2352 by 1568 pixels — 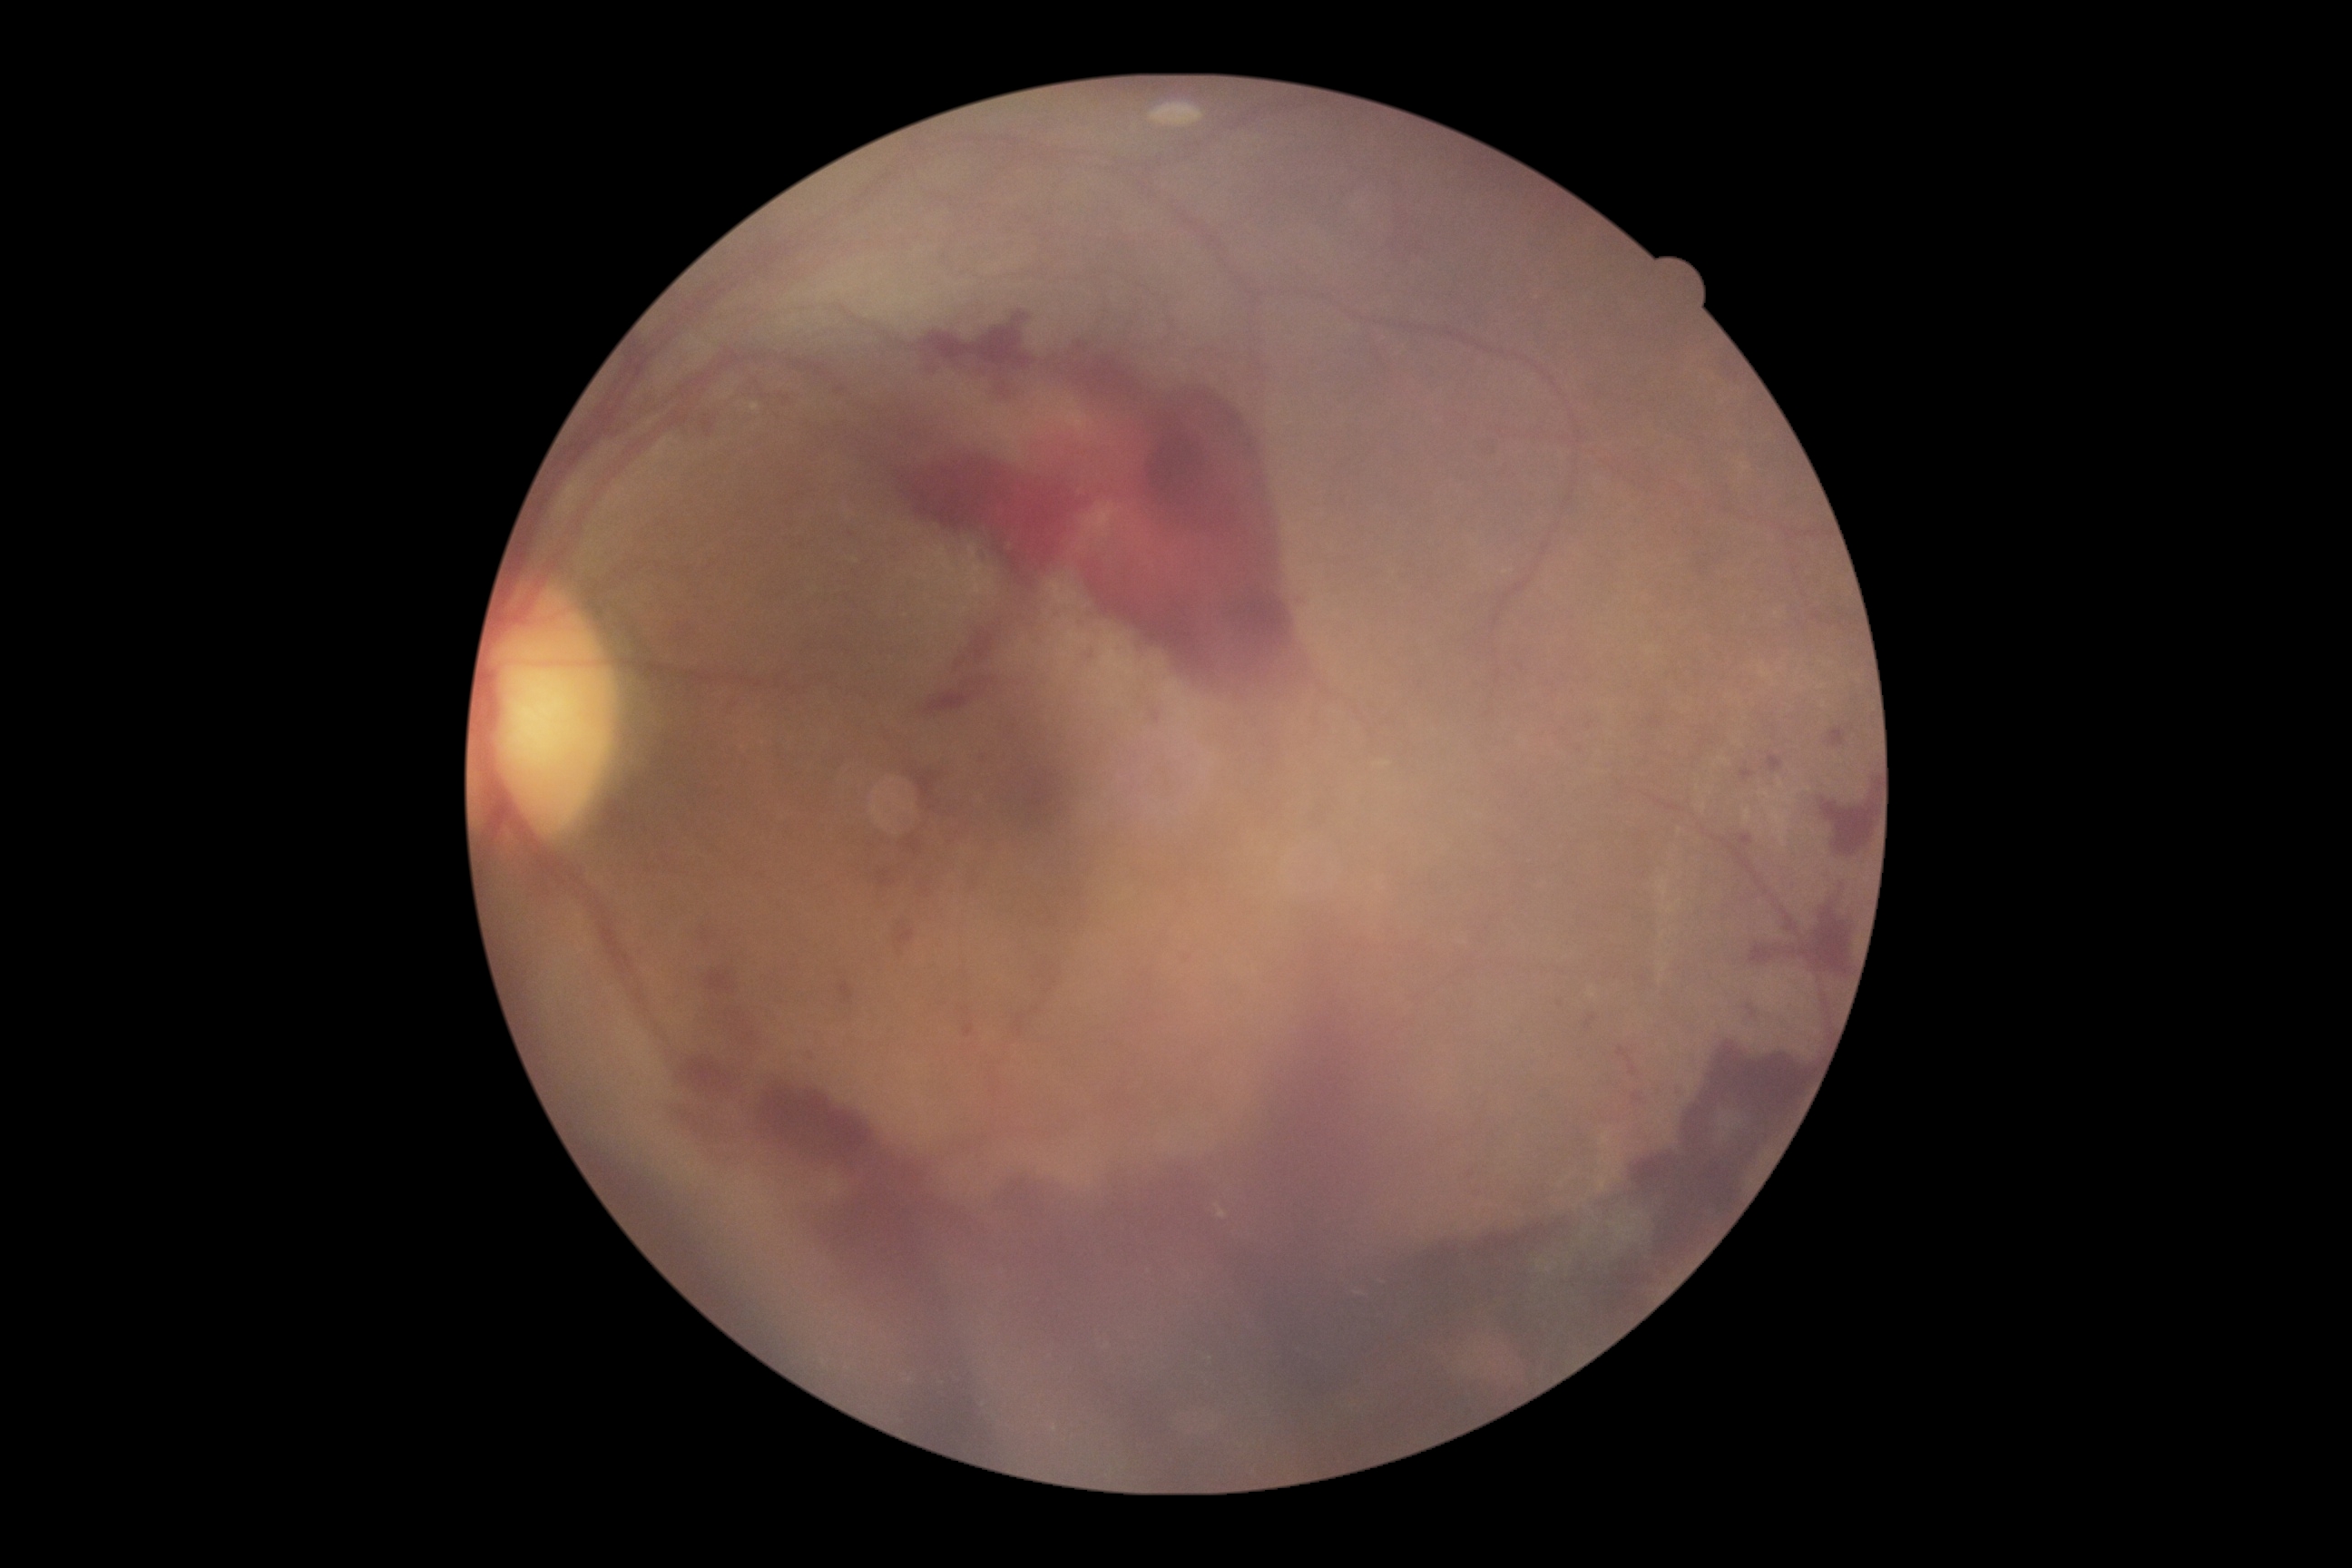
The retinopathy is classified as proliferative diabetic retinopathy. Diabetic retinopathy grade: 4/4 — neovascularization and/or vitreous/pre-retinal hemorrhage.